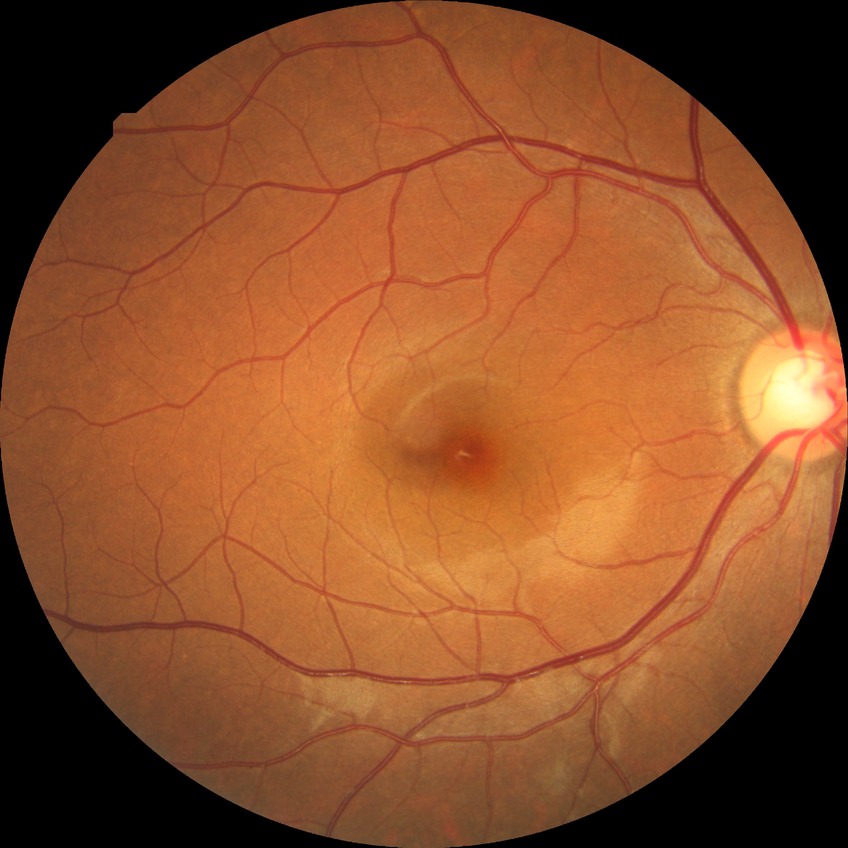

Annotations:
- diabetic retinopathy (DR) — no diabetic retinopathy (NDR)